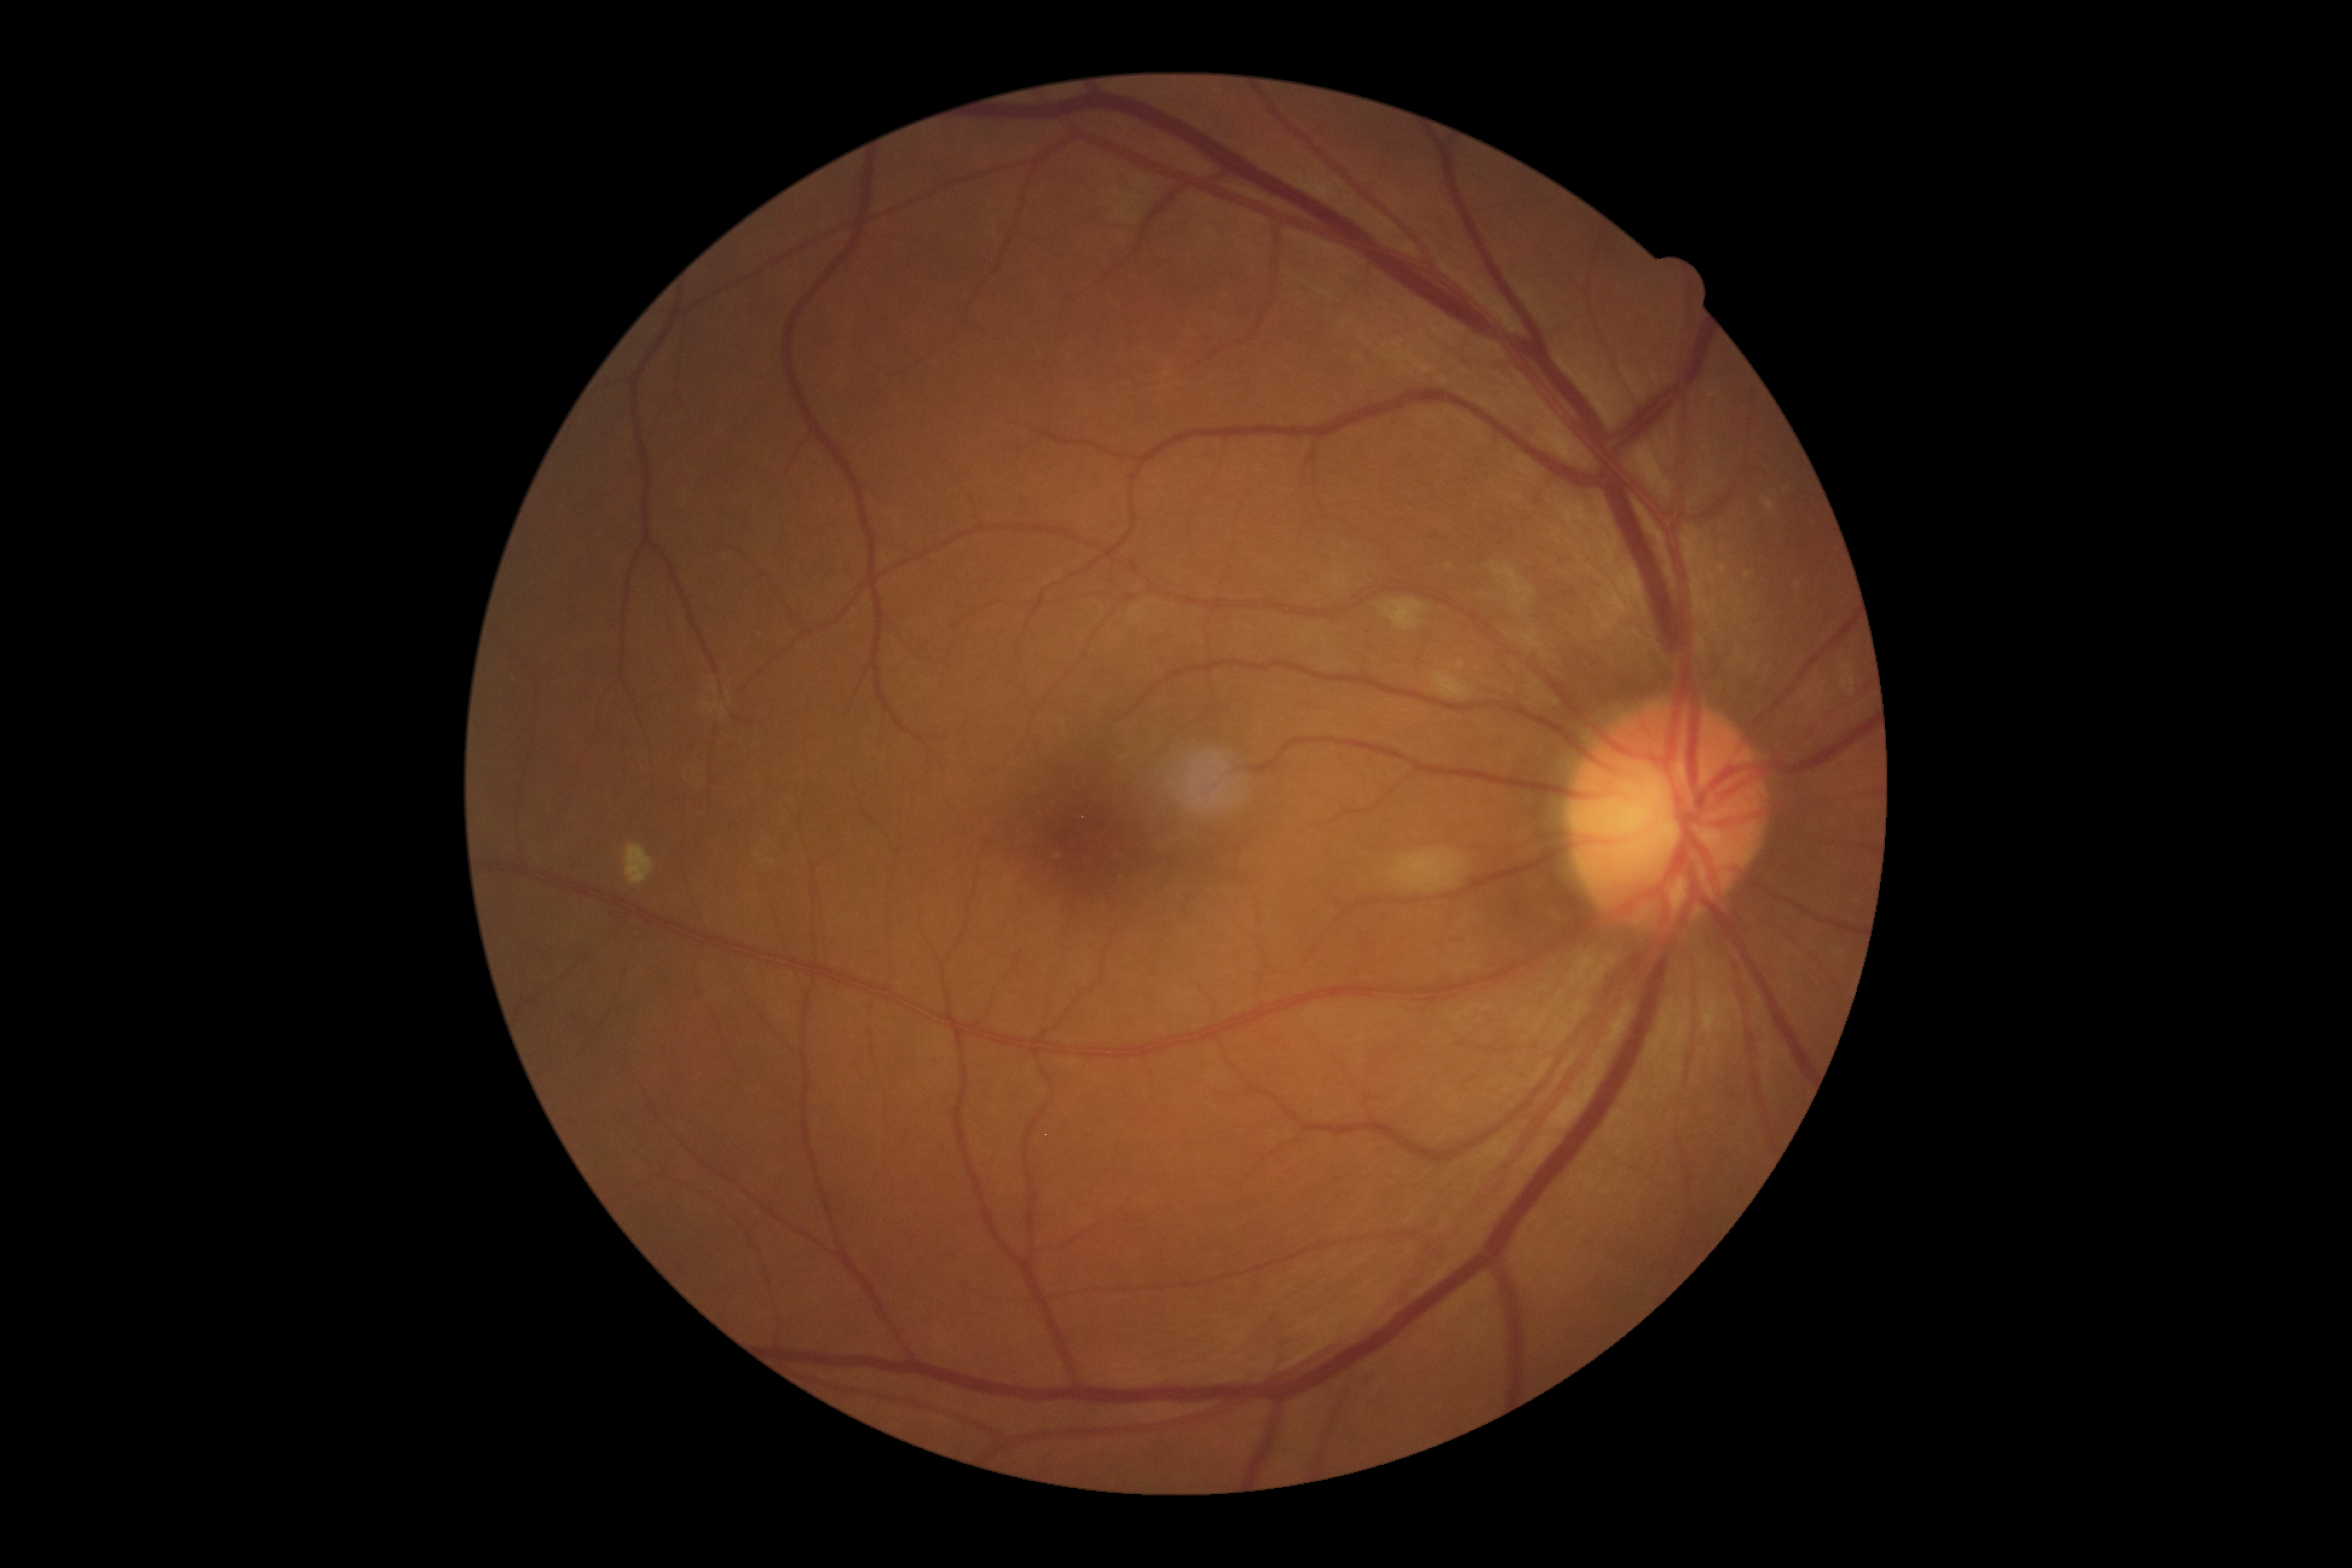

Diabetic retinopathy severity: grade 2 (moderate NPDR).